Fundus photo, 45° field of view
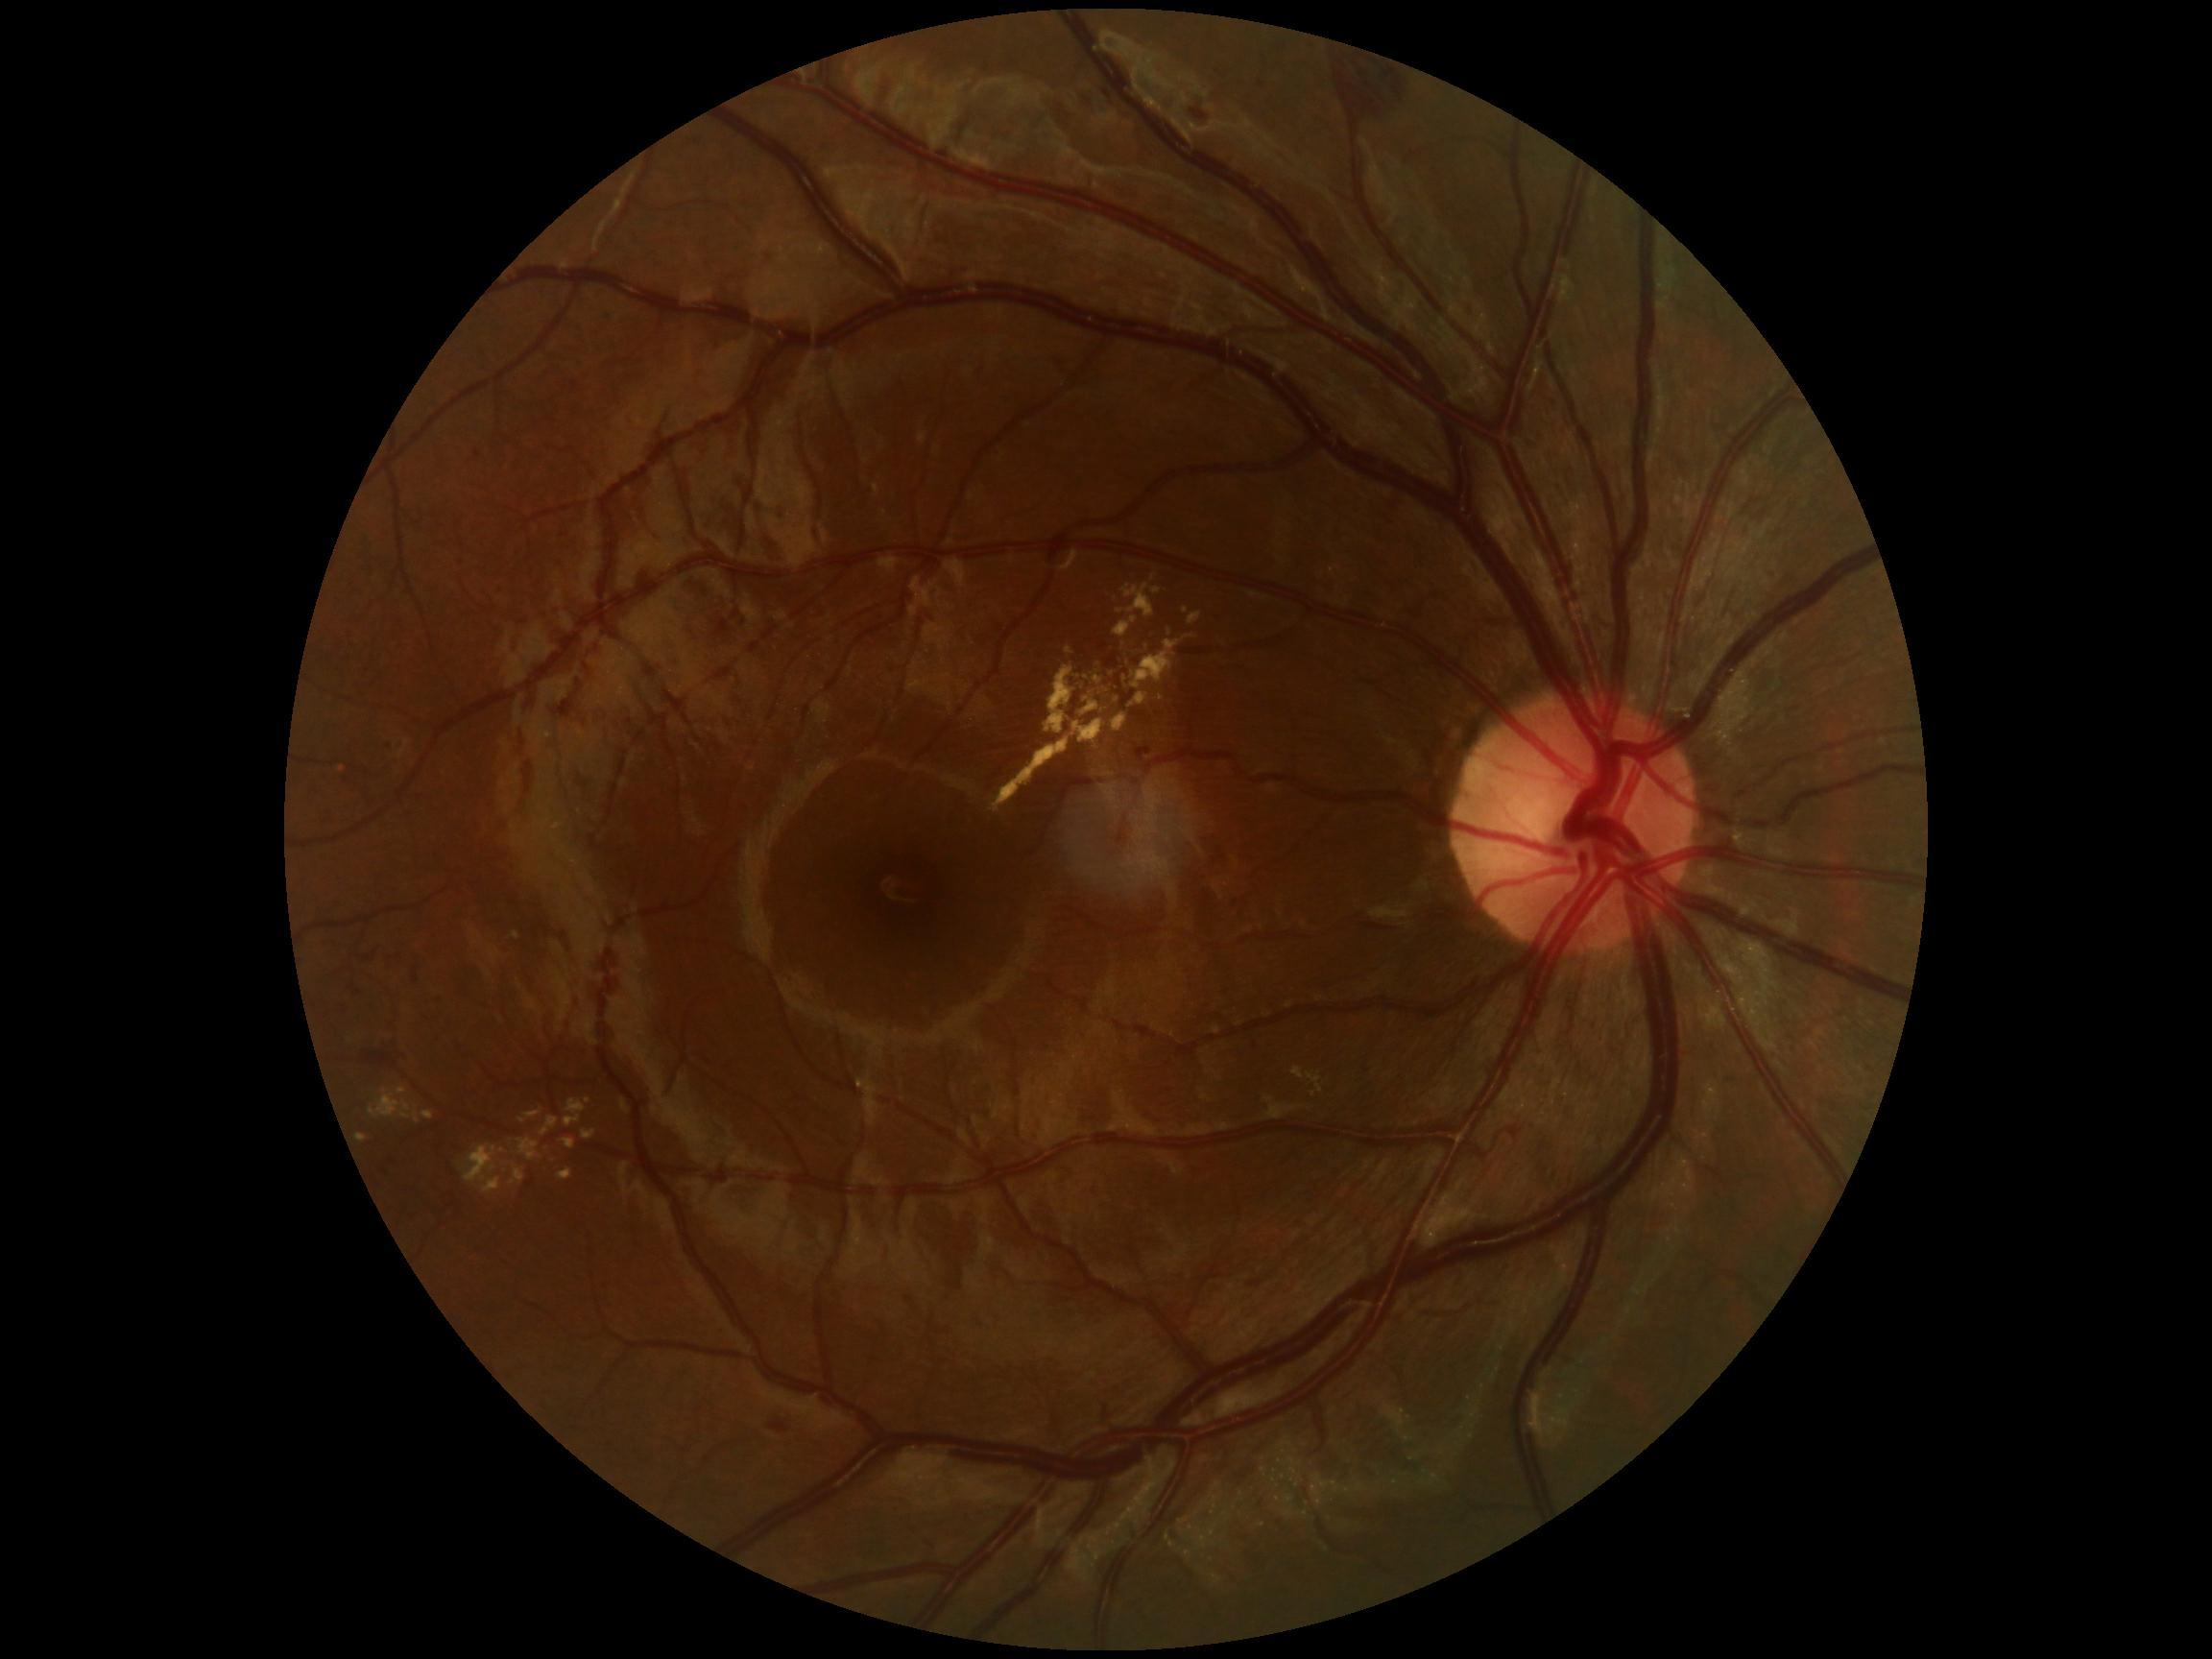
Diabetic retinopathy (DR) is moderate non-proliferative diabetic retinopathy (grade 2) — more than just microaneurysms but less than severe NPDR
Selected lesions:
- hard exudates (EXs) (subset): 1292, 1069, 1305, 1080; 990, 737, 1070, 813; 421, 1112, 435, 1121; 510, 1165, 526, 1186; 1113, 713, 1127, 733; 1072, 720, 1104, 744; 582, 1130, 597, 1141; 1123, 679, 1130, 688; 1094, 677, 1102, 685; 518, 1140, 541, 1162; 1045, 667, 1075, 734
- Small EXs approximately at point(1086, 699); point(1121, 612); point(1313, 1095); point(1169, 633); point(1186, 639)
- microaneurysms (MAs) (subset): 388, 742, 395, 751; 474, 450, 481, 458; 1142, 747, 1152, 756; 354, 990, 362, 997; 348, 987, 356, 992; 400, 744, 407, 754
- hemorrhages (HEs) (subset): 1192, 109, 1207, 121; 366, 1051, 399, 1067; 1345, 54, 1407, 113; 361, 944, 383, 964; 770, 1424, 789, 1433; 412, 968, 419, 985
- soft exudates (SEs): none identified